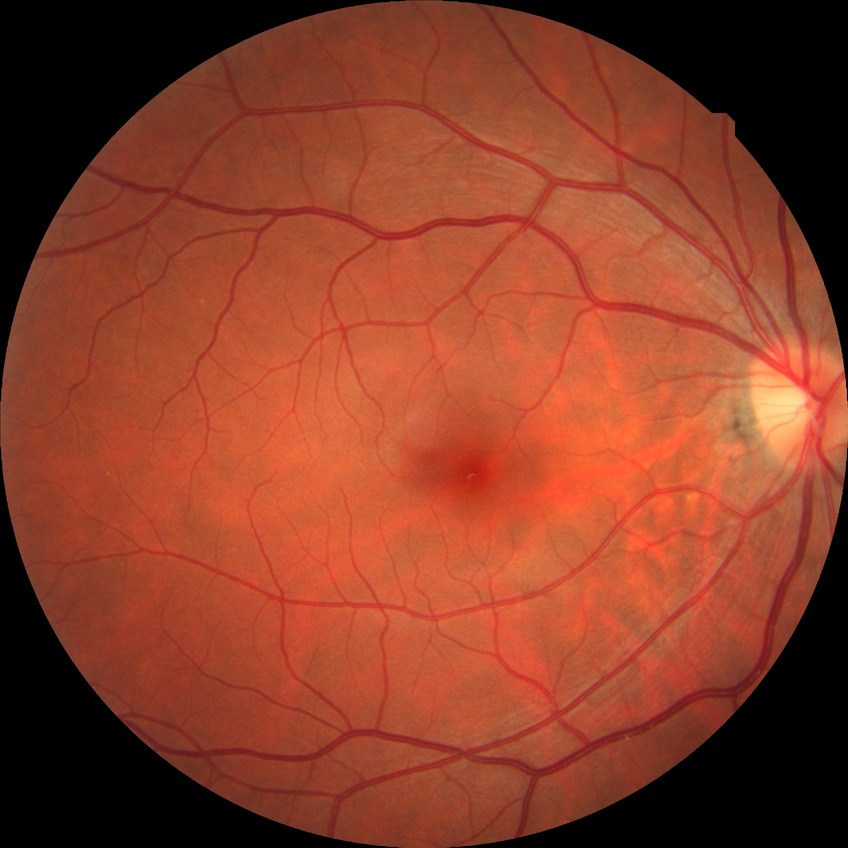

diabetic retinopathy (DR): no diabetic retinopathy (NDR)